Wide-field fundus photograph of an infant
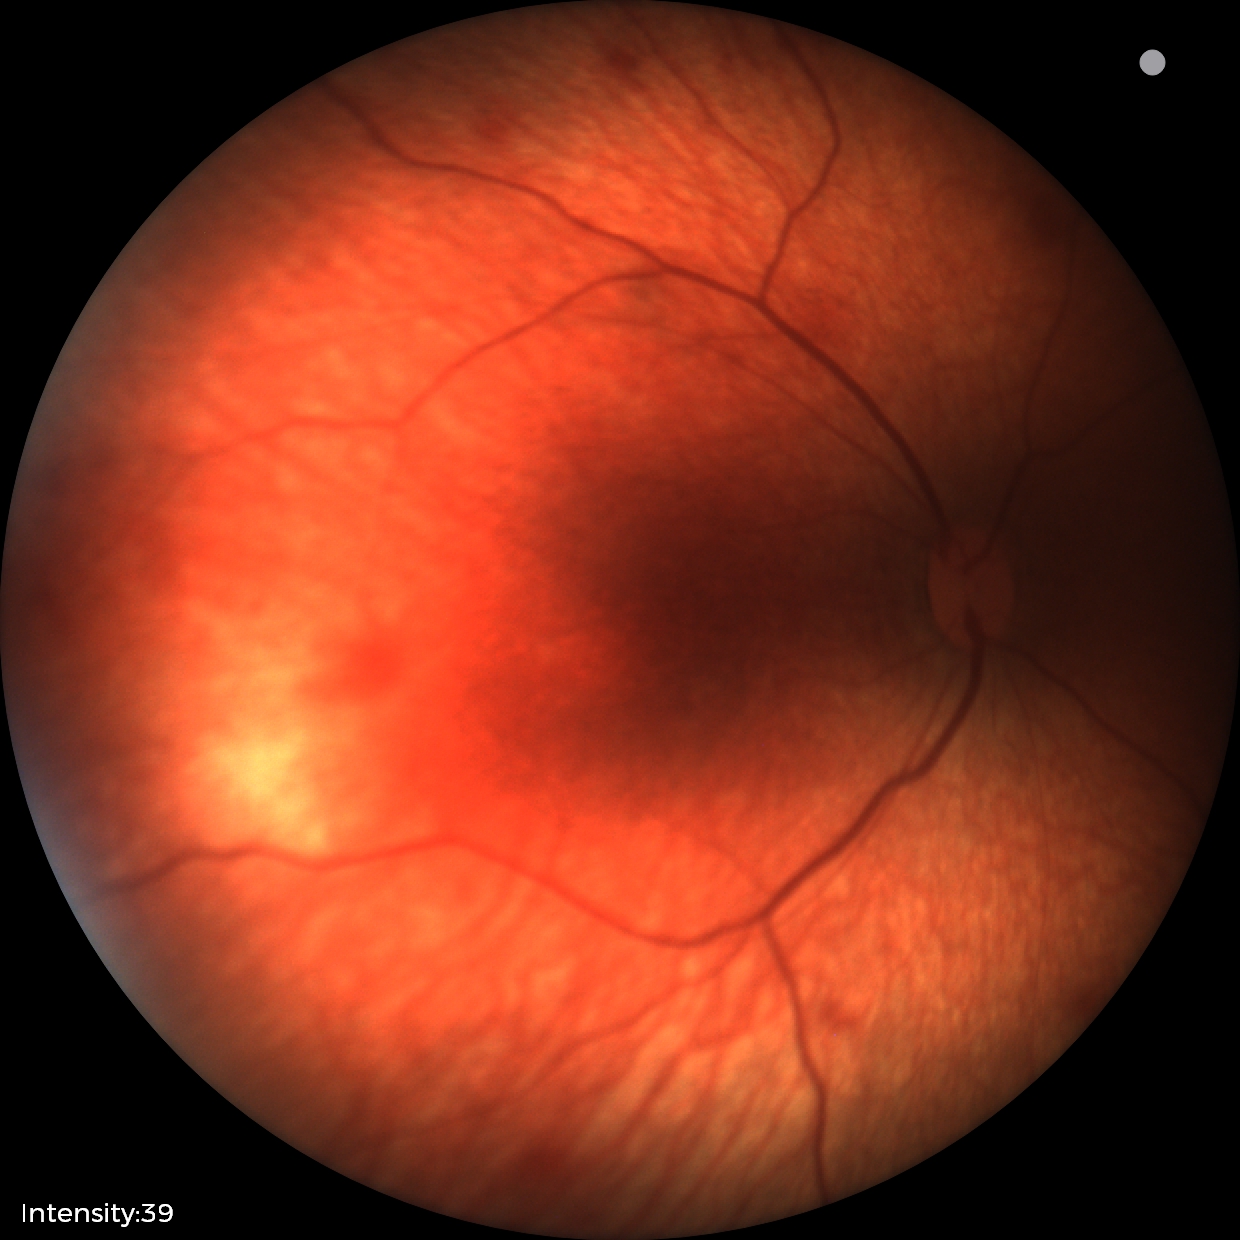

Diagnosis from this screening exam: retinal hemorrhages.